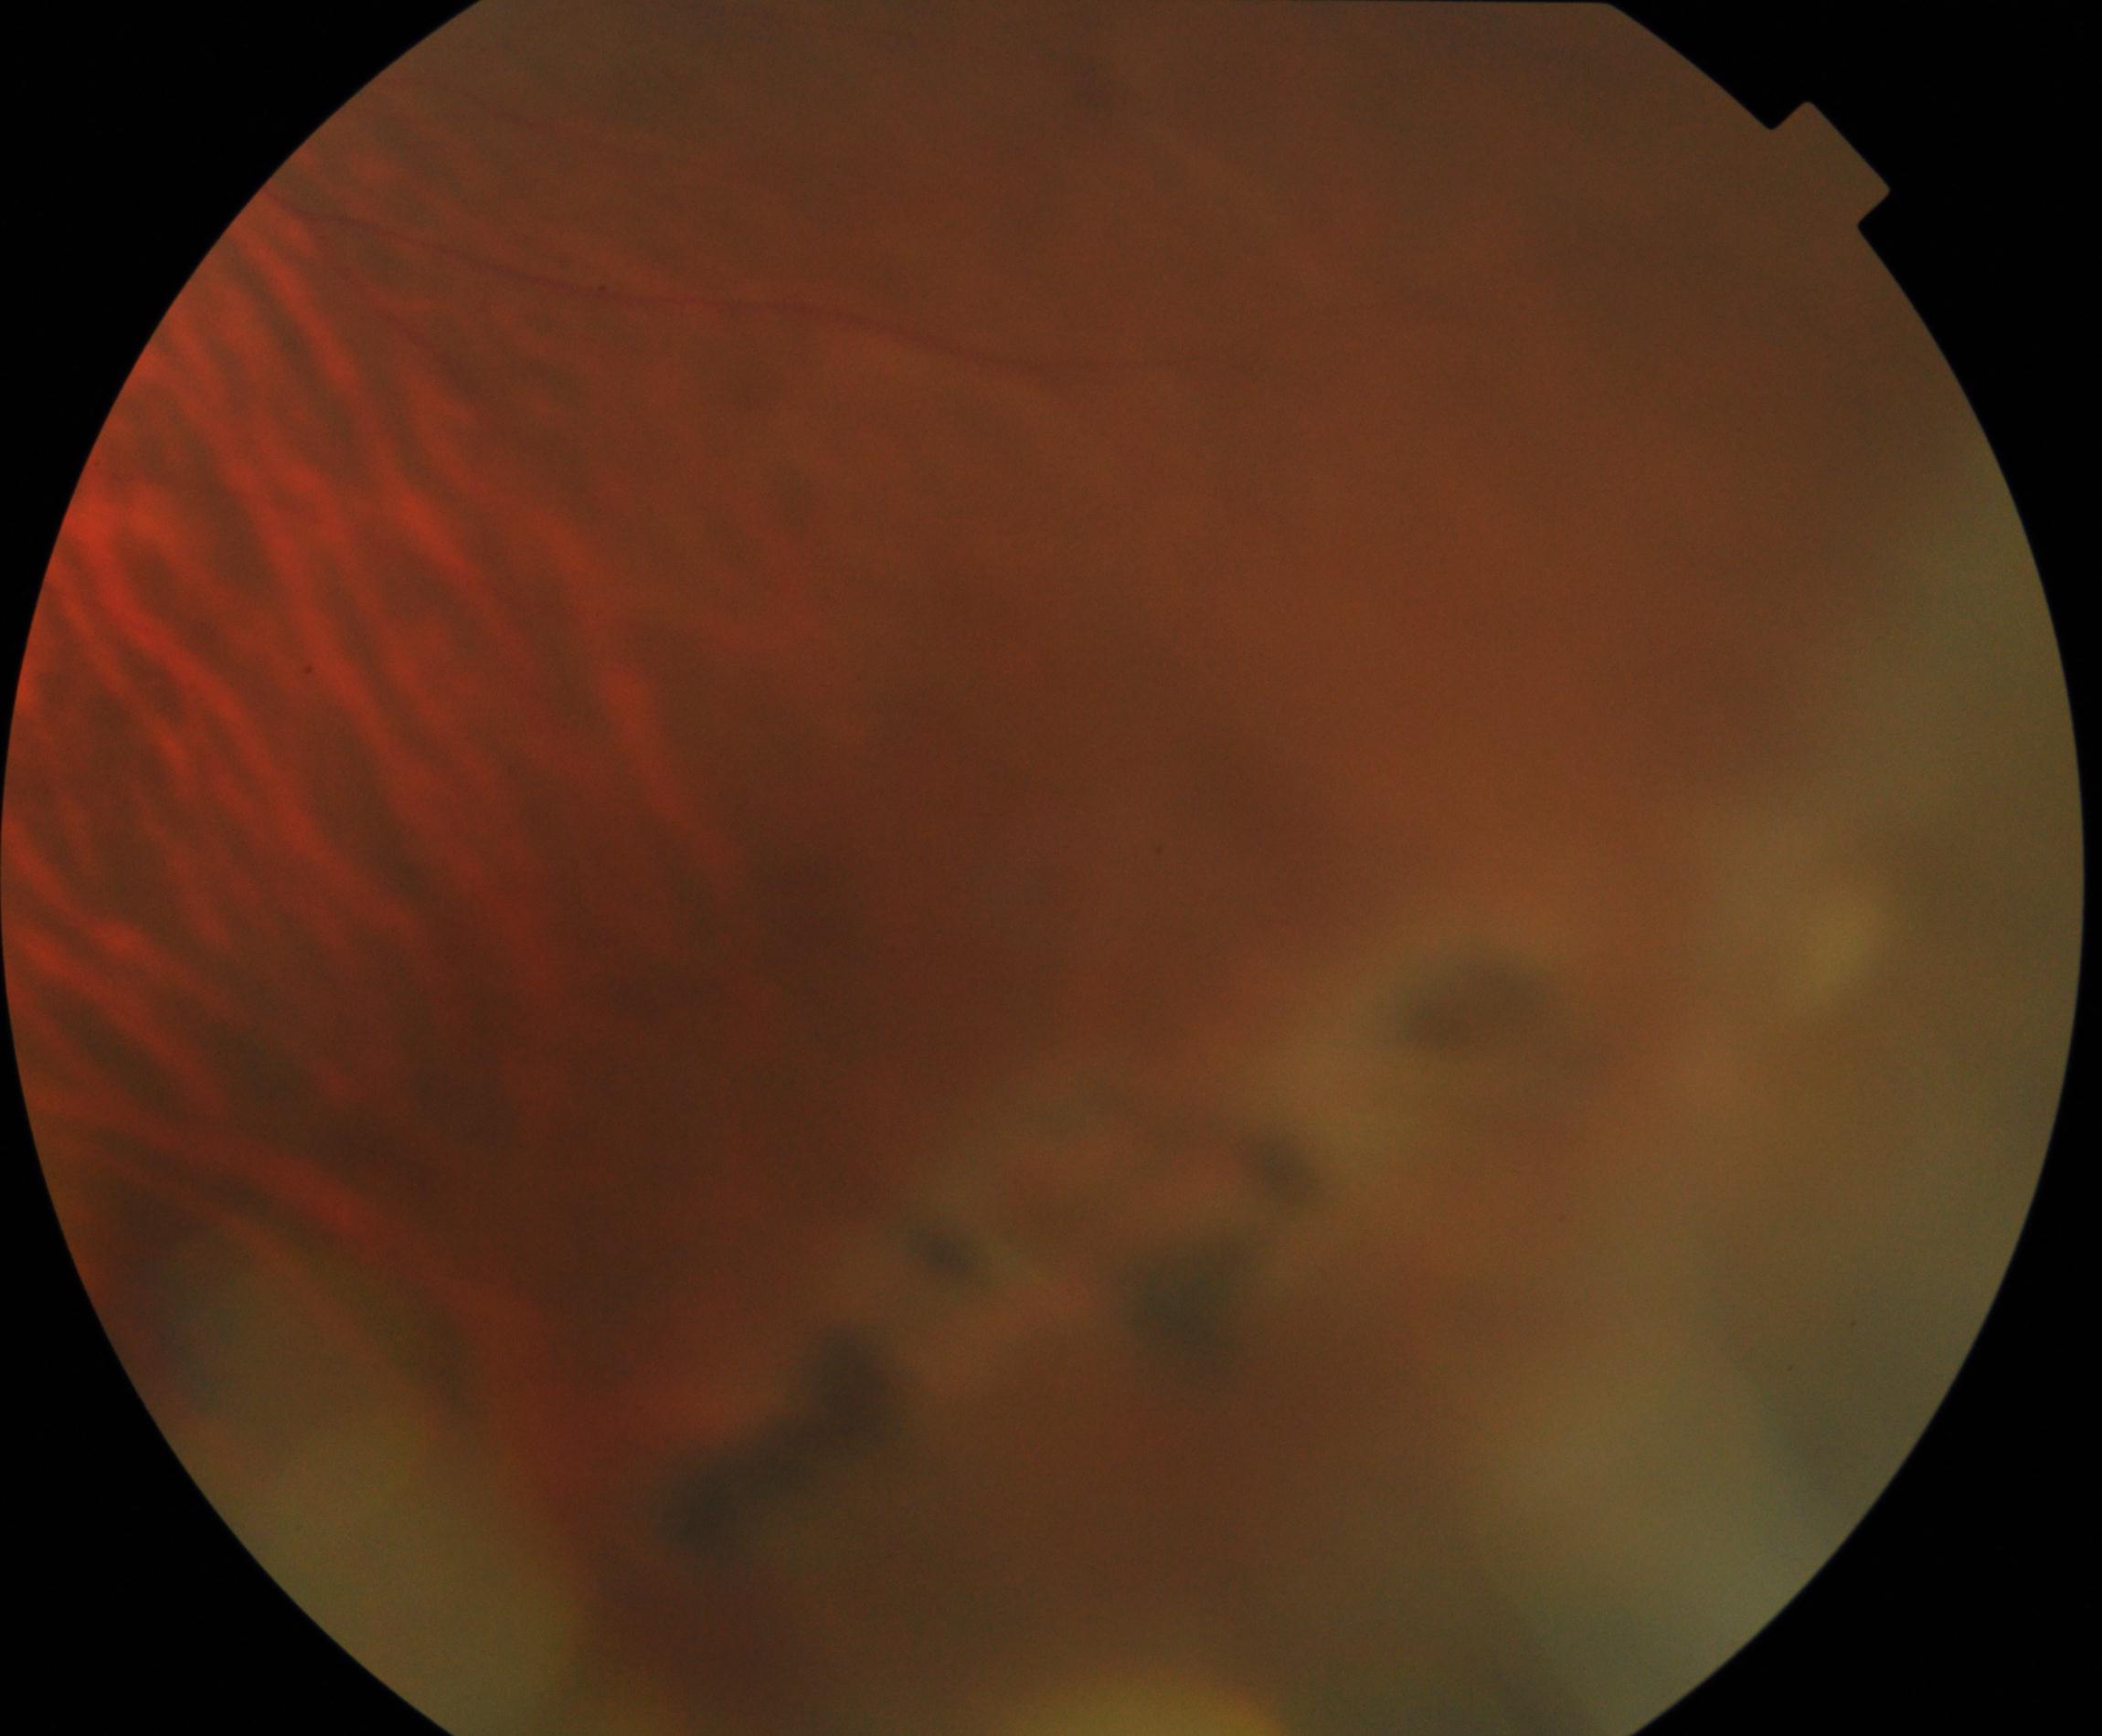 There is evidence of peripheral retinal degeneration and break. Typically showing lattice, snailtrack, pavingstone, honeycomb, peripheral drusen, microcystoid, or white-without-pressure degeneration, sometimes with a retinal break.